Tabletop color fundus camera image; image size 1924x1556
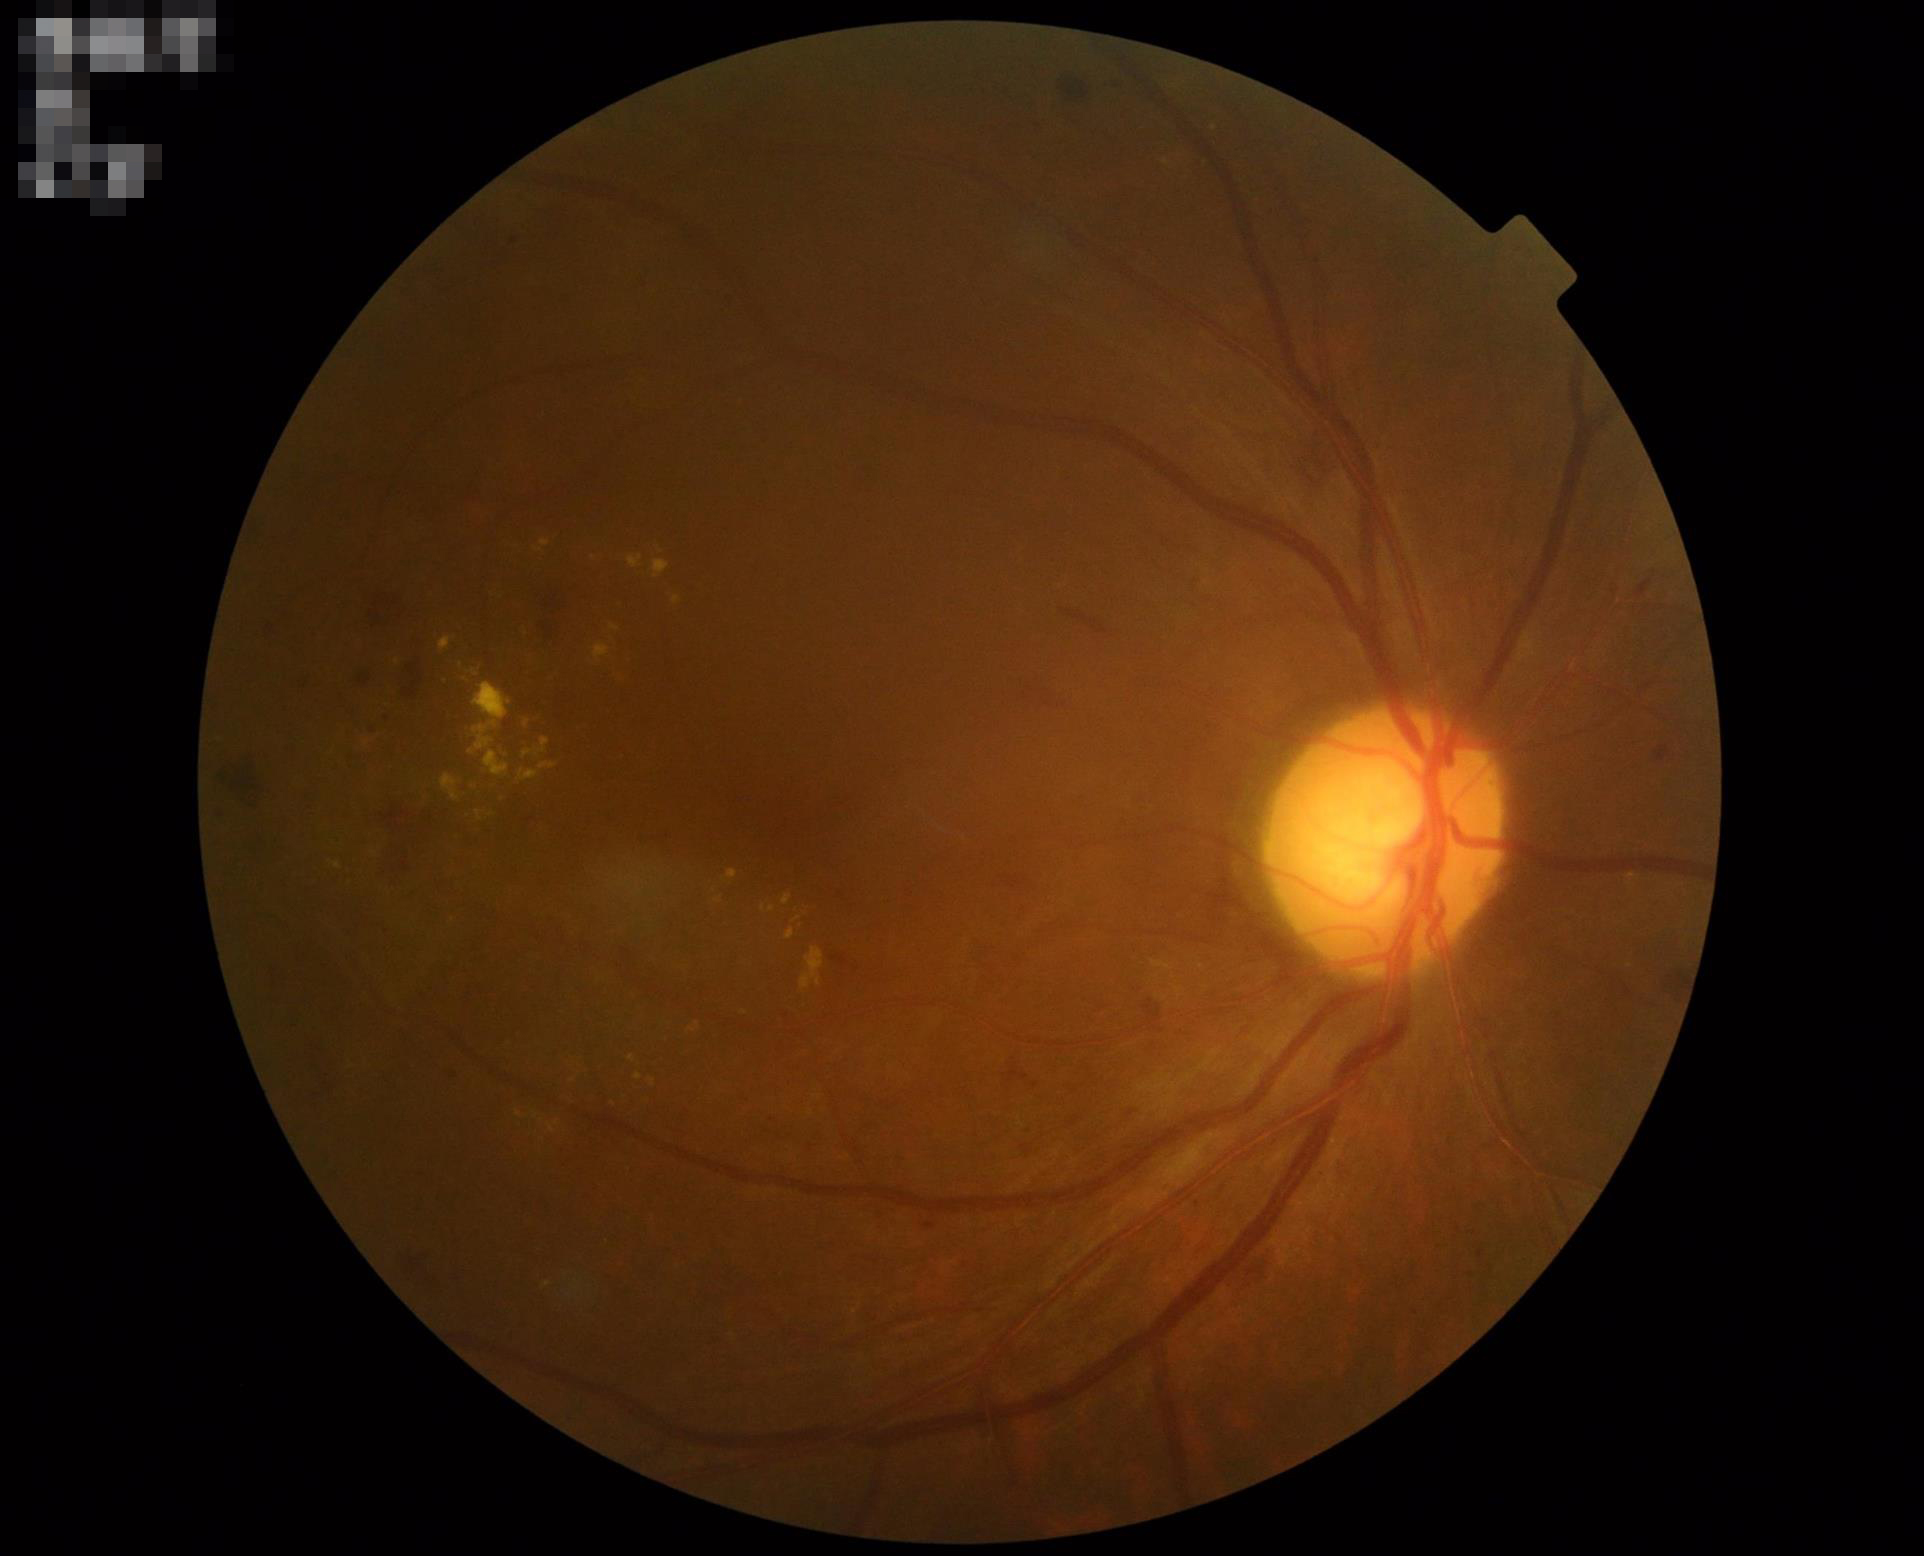 Overall quality = adequate | Sharpness = clear | Illumination = even.